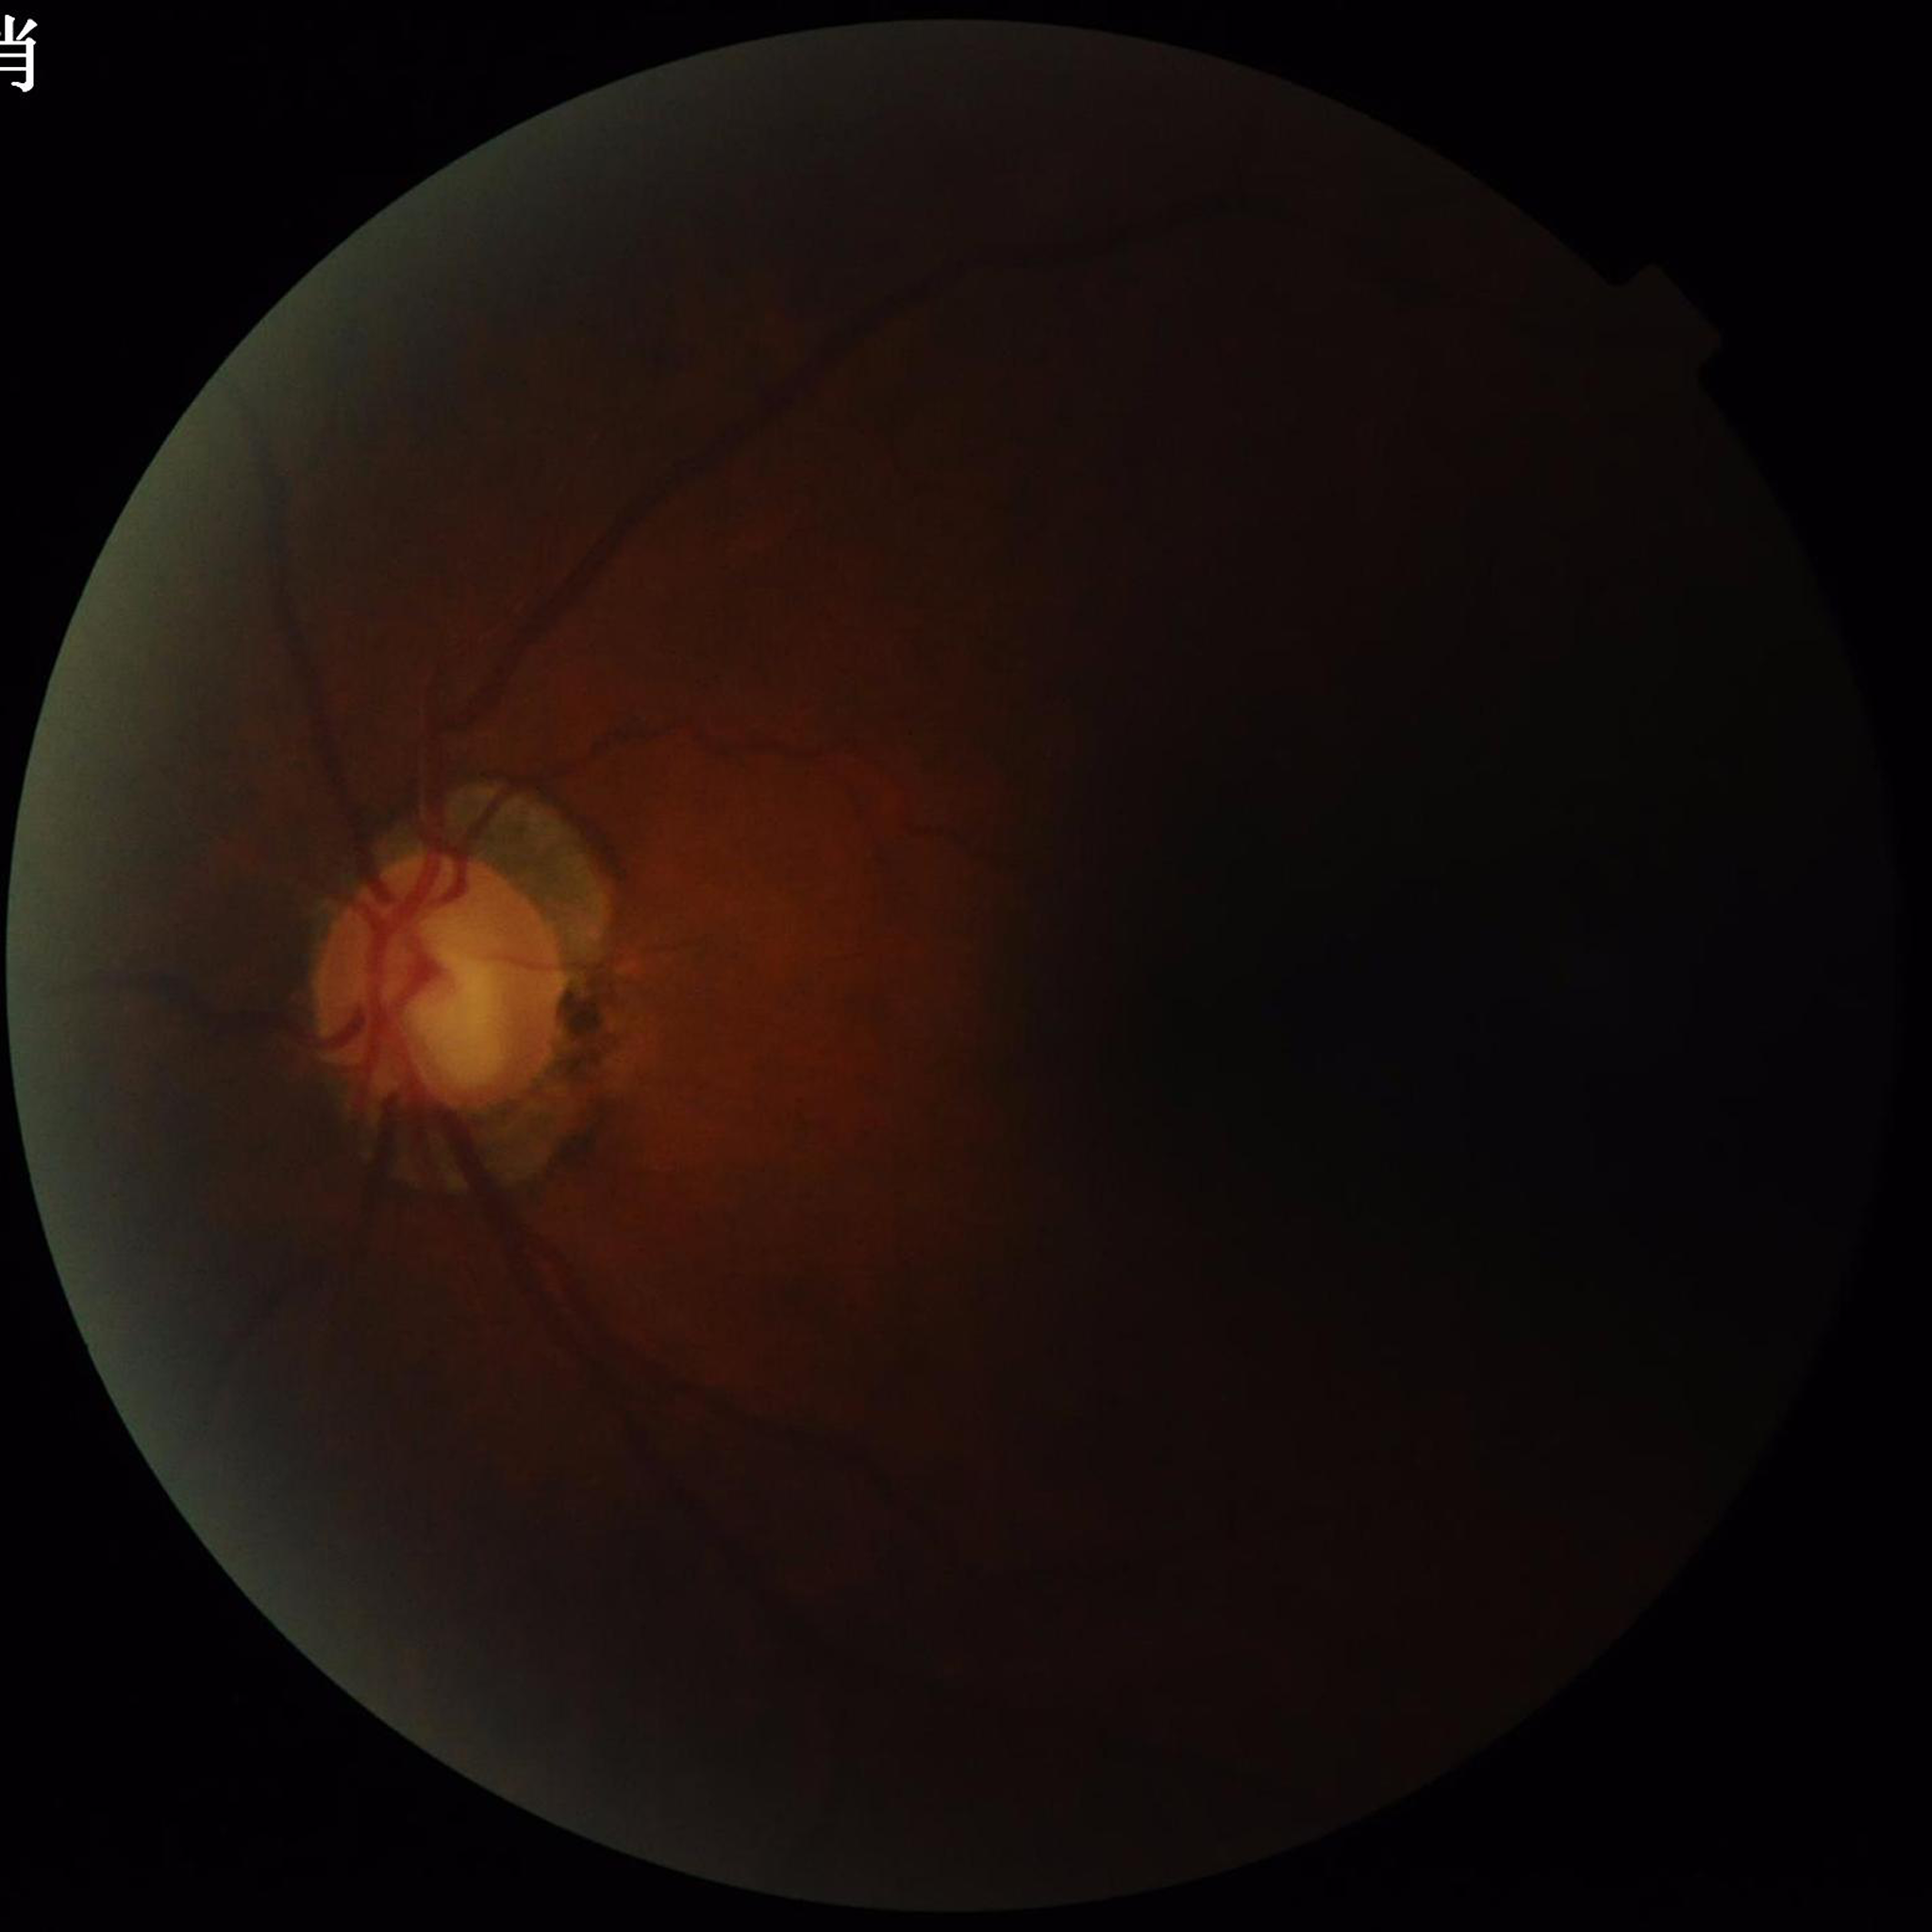
Condition: glaucoma | Photo quality: suboptimal — low contrast, illumination/color distortion, blur.